Acquired with a Nidek AFC-330 · 240 by 240 pixels
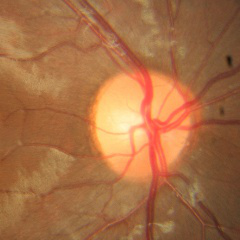

Fundus appearance consistent with no glaucoma.